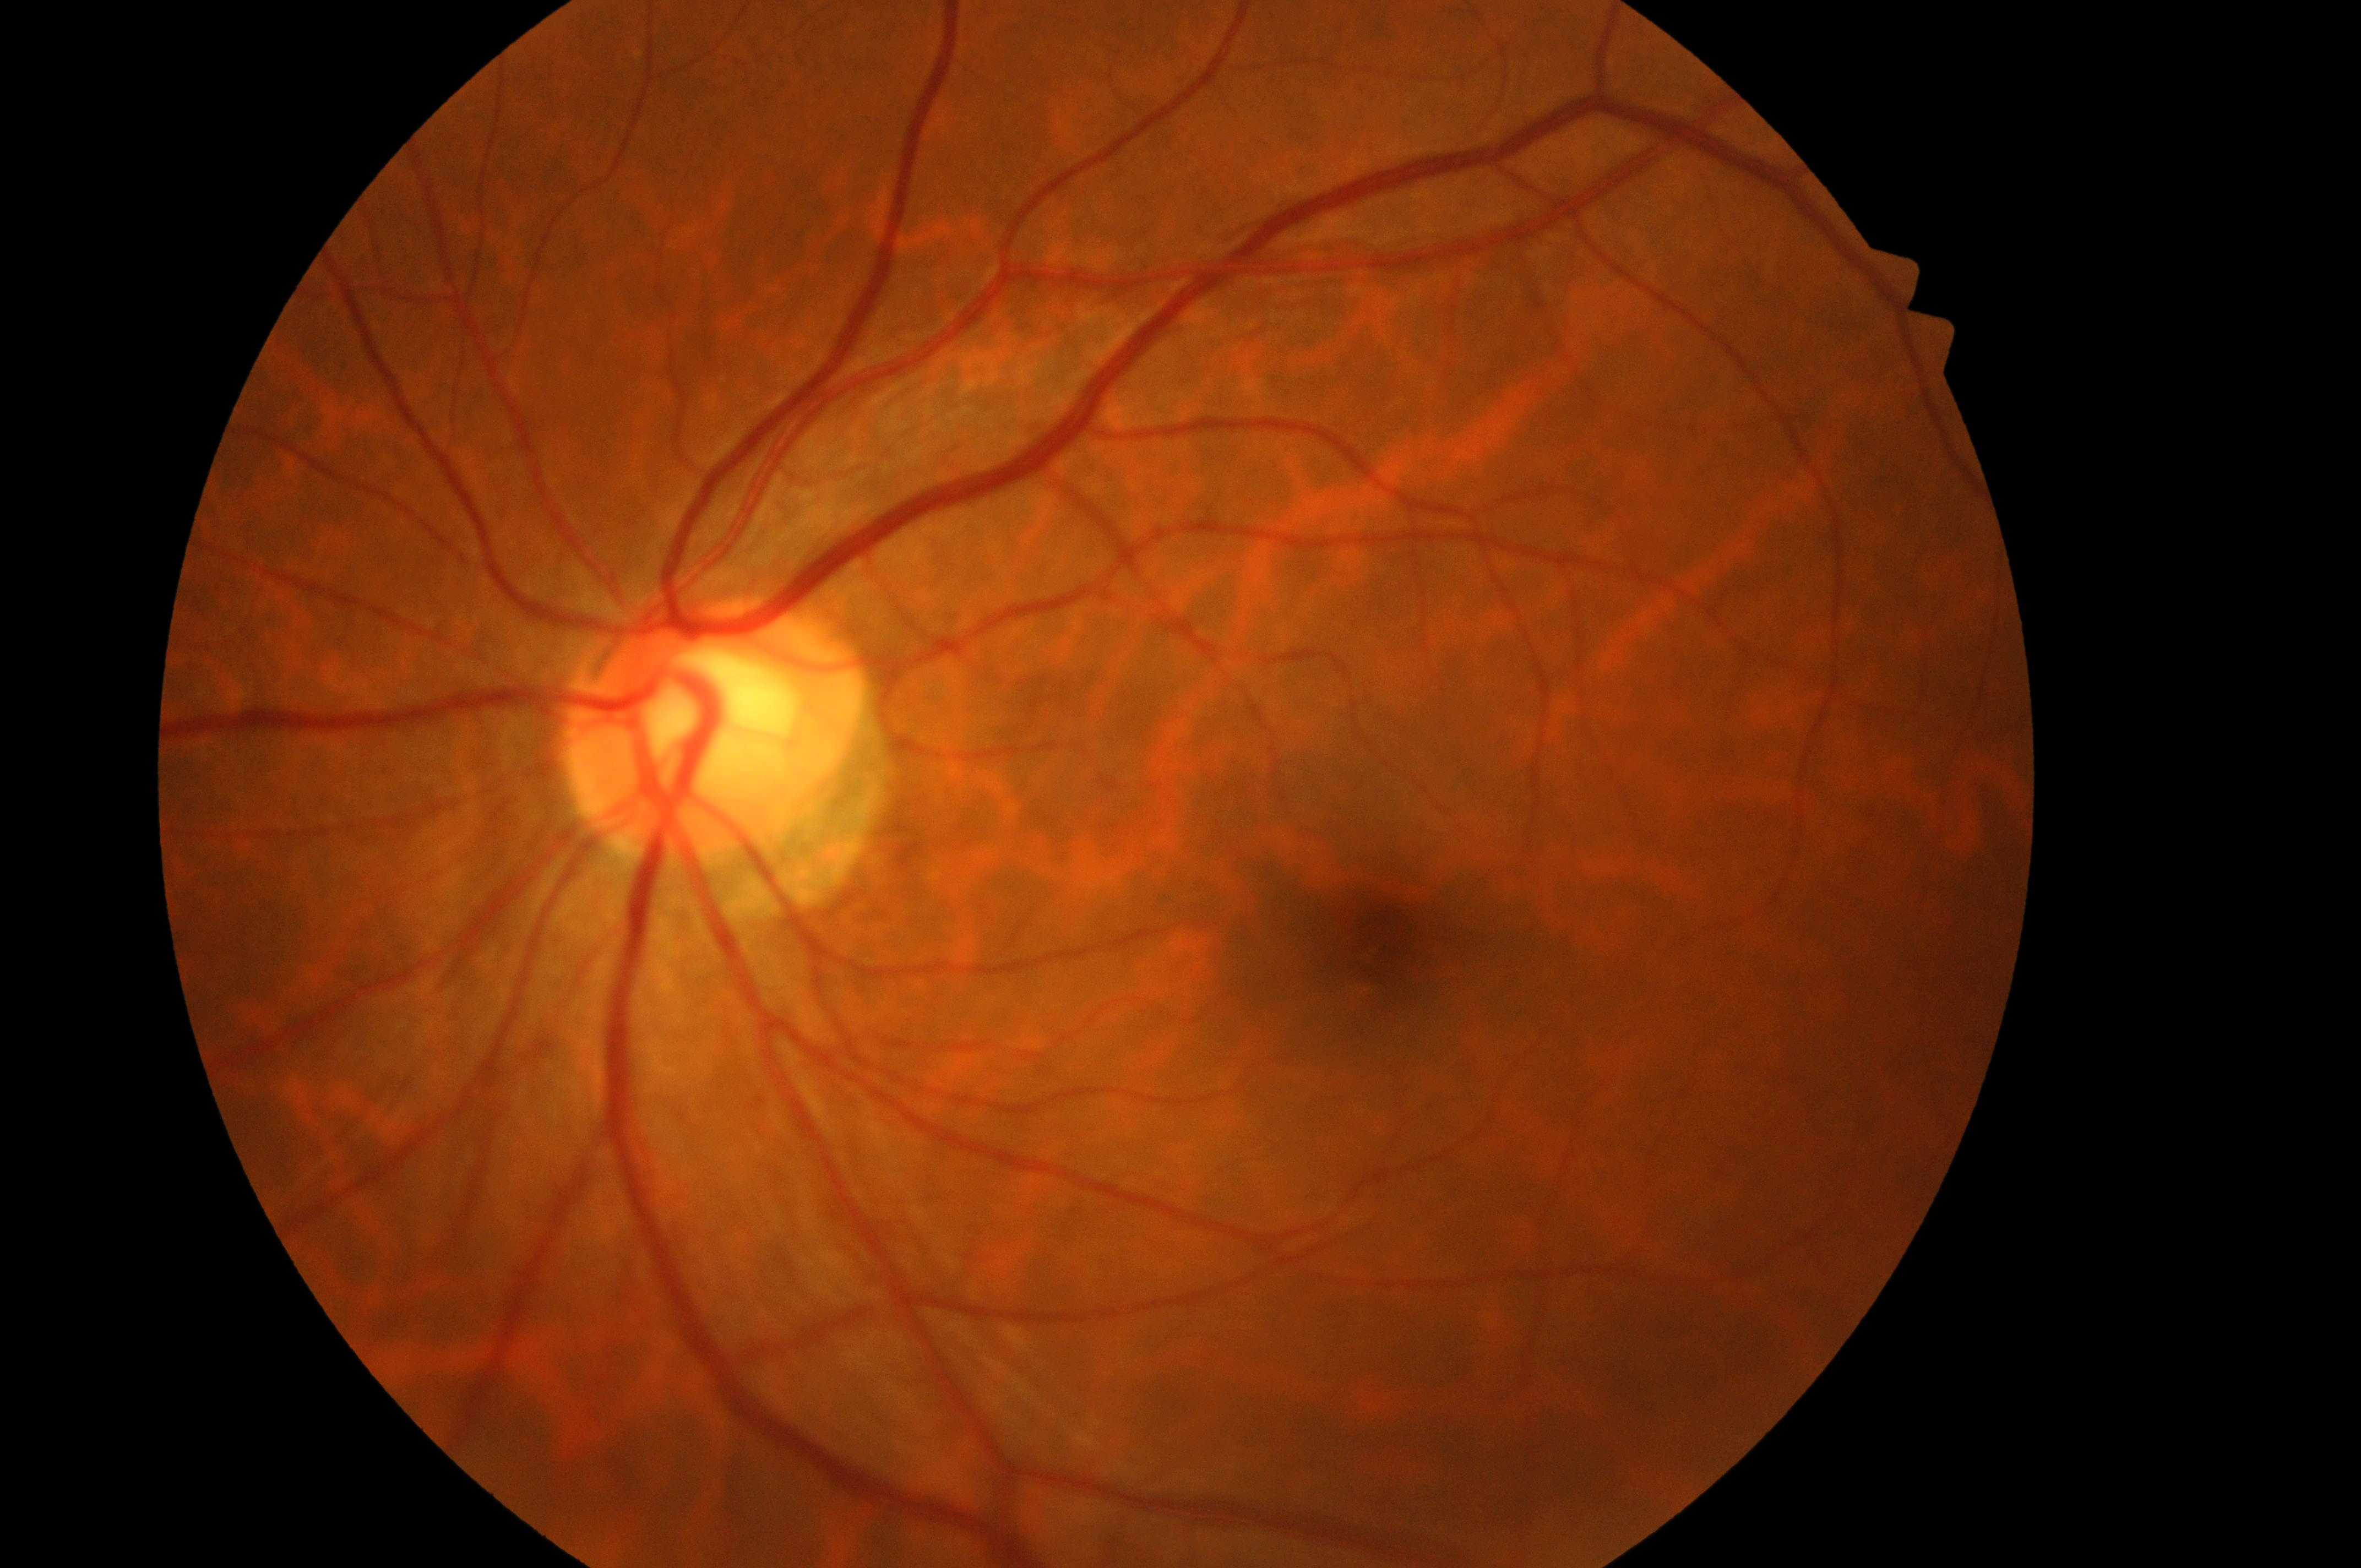

* DR — no apparent diabetic retinopathy (grade 0)
* optic disc — (707,734)
* DR impression — No DR or DME findings
* eye — OS
* foveal center — (1388,942)
* DME — grade 0 (no risk)